1932 by 1916 pixels · retinal fundus photograph.
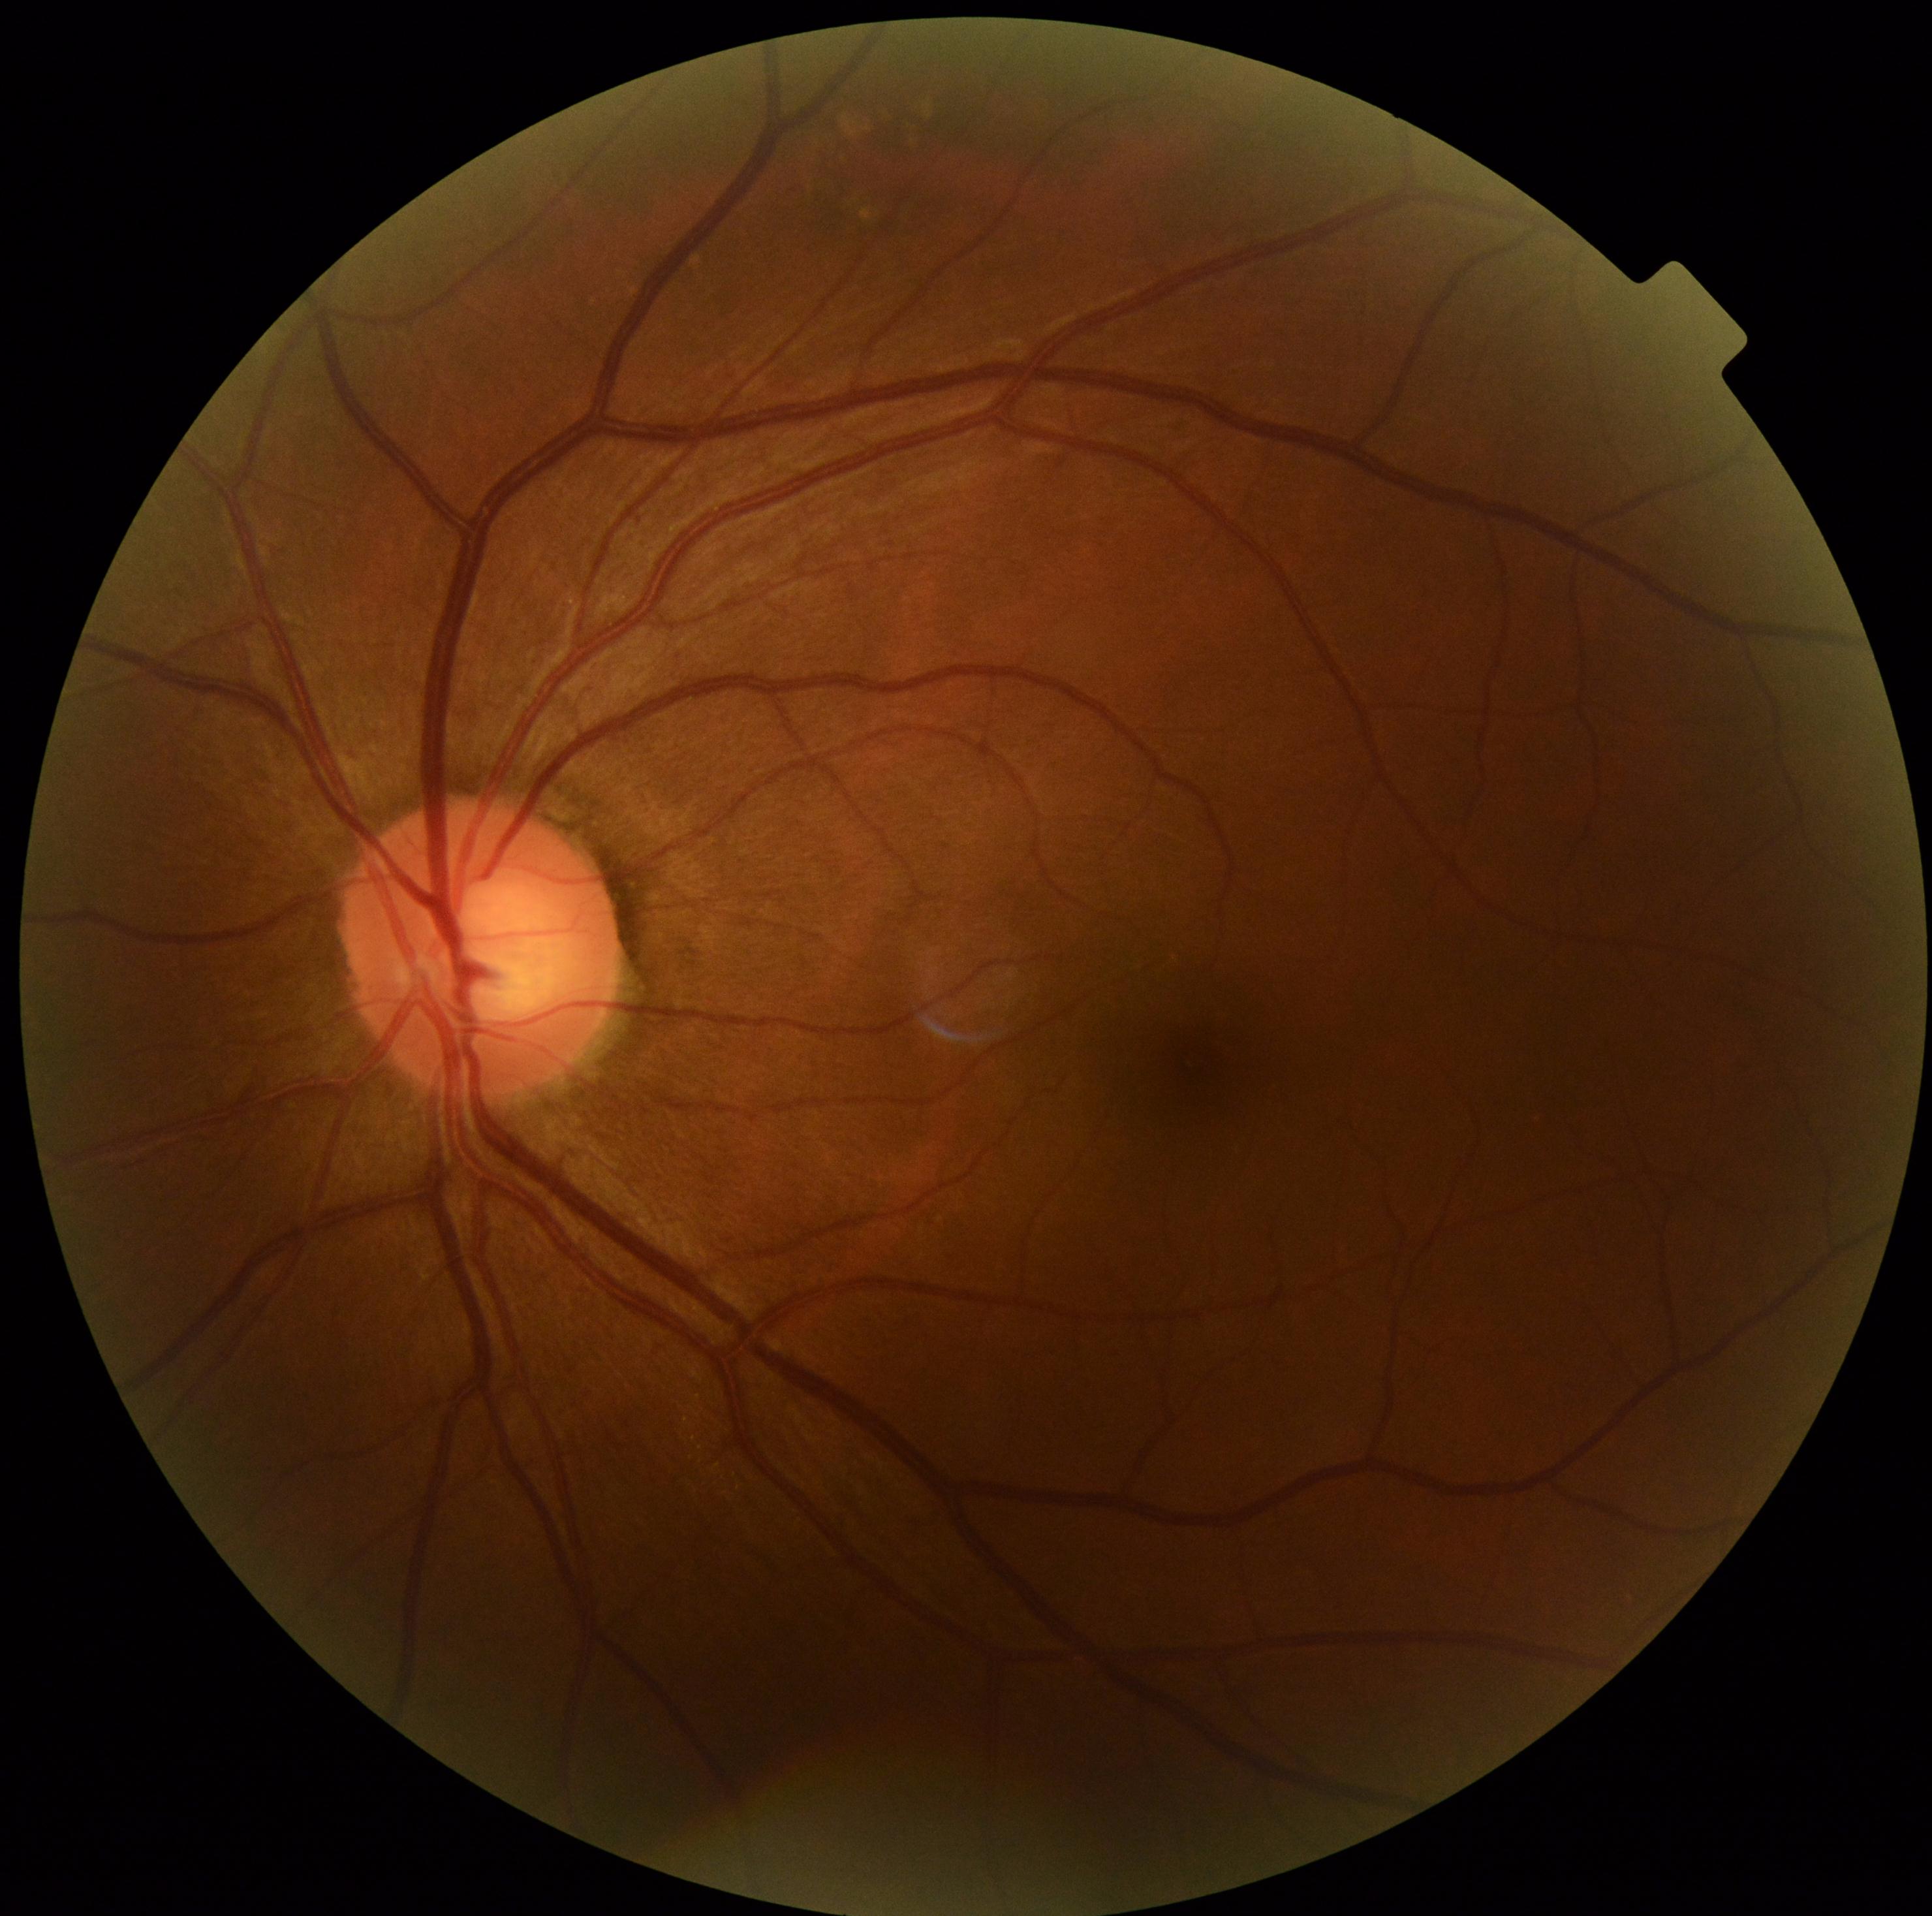
DR severity is grade 0 — no visible signs of diabetic retinopathy.